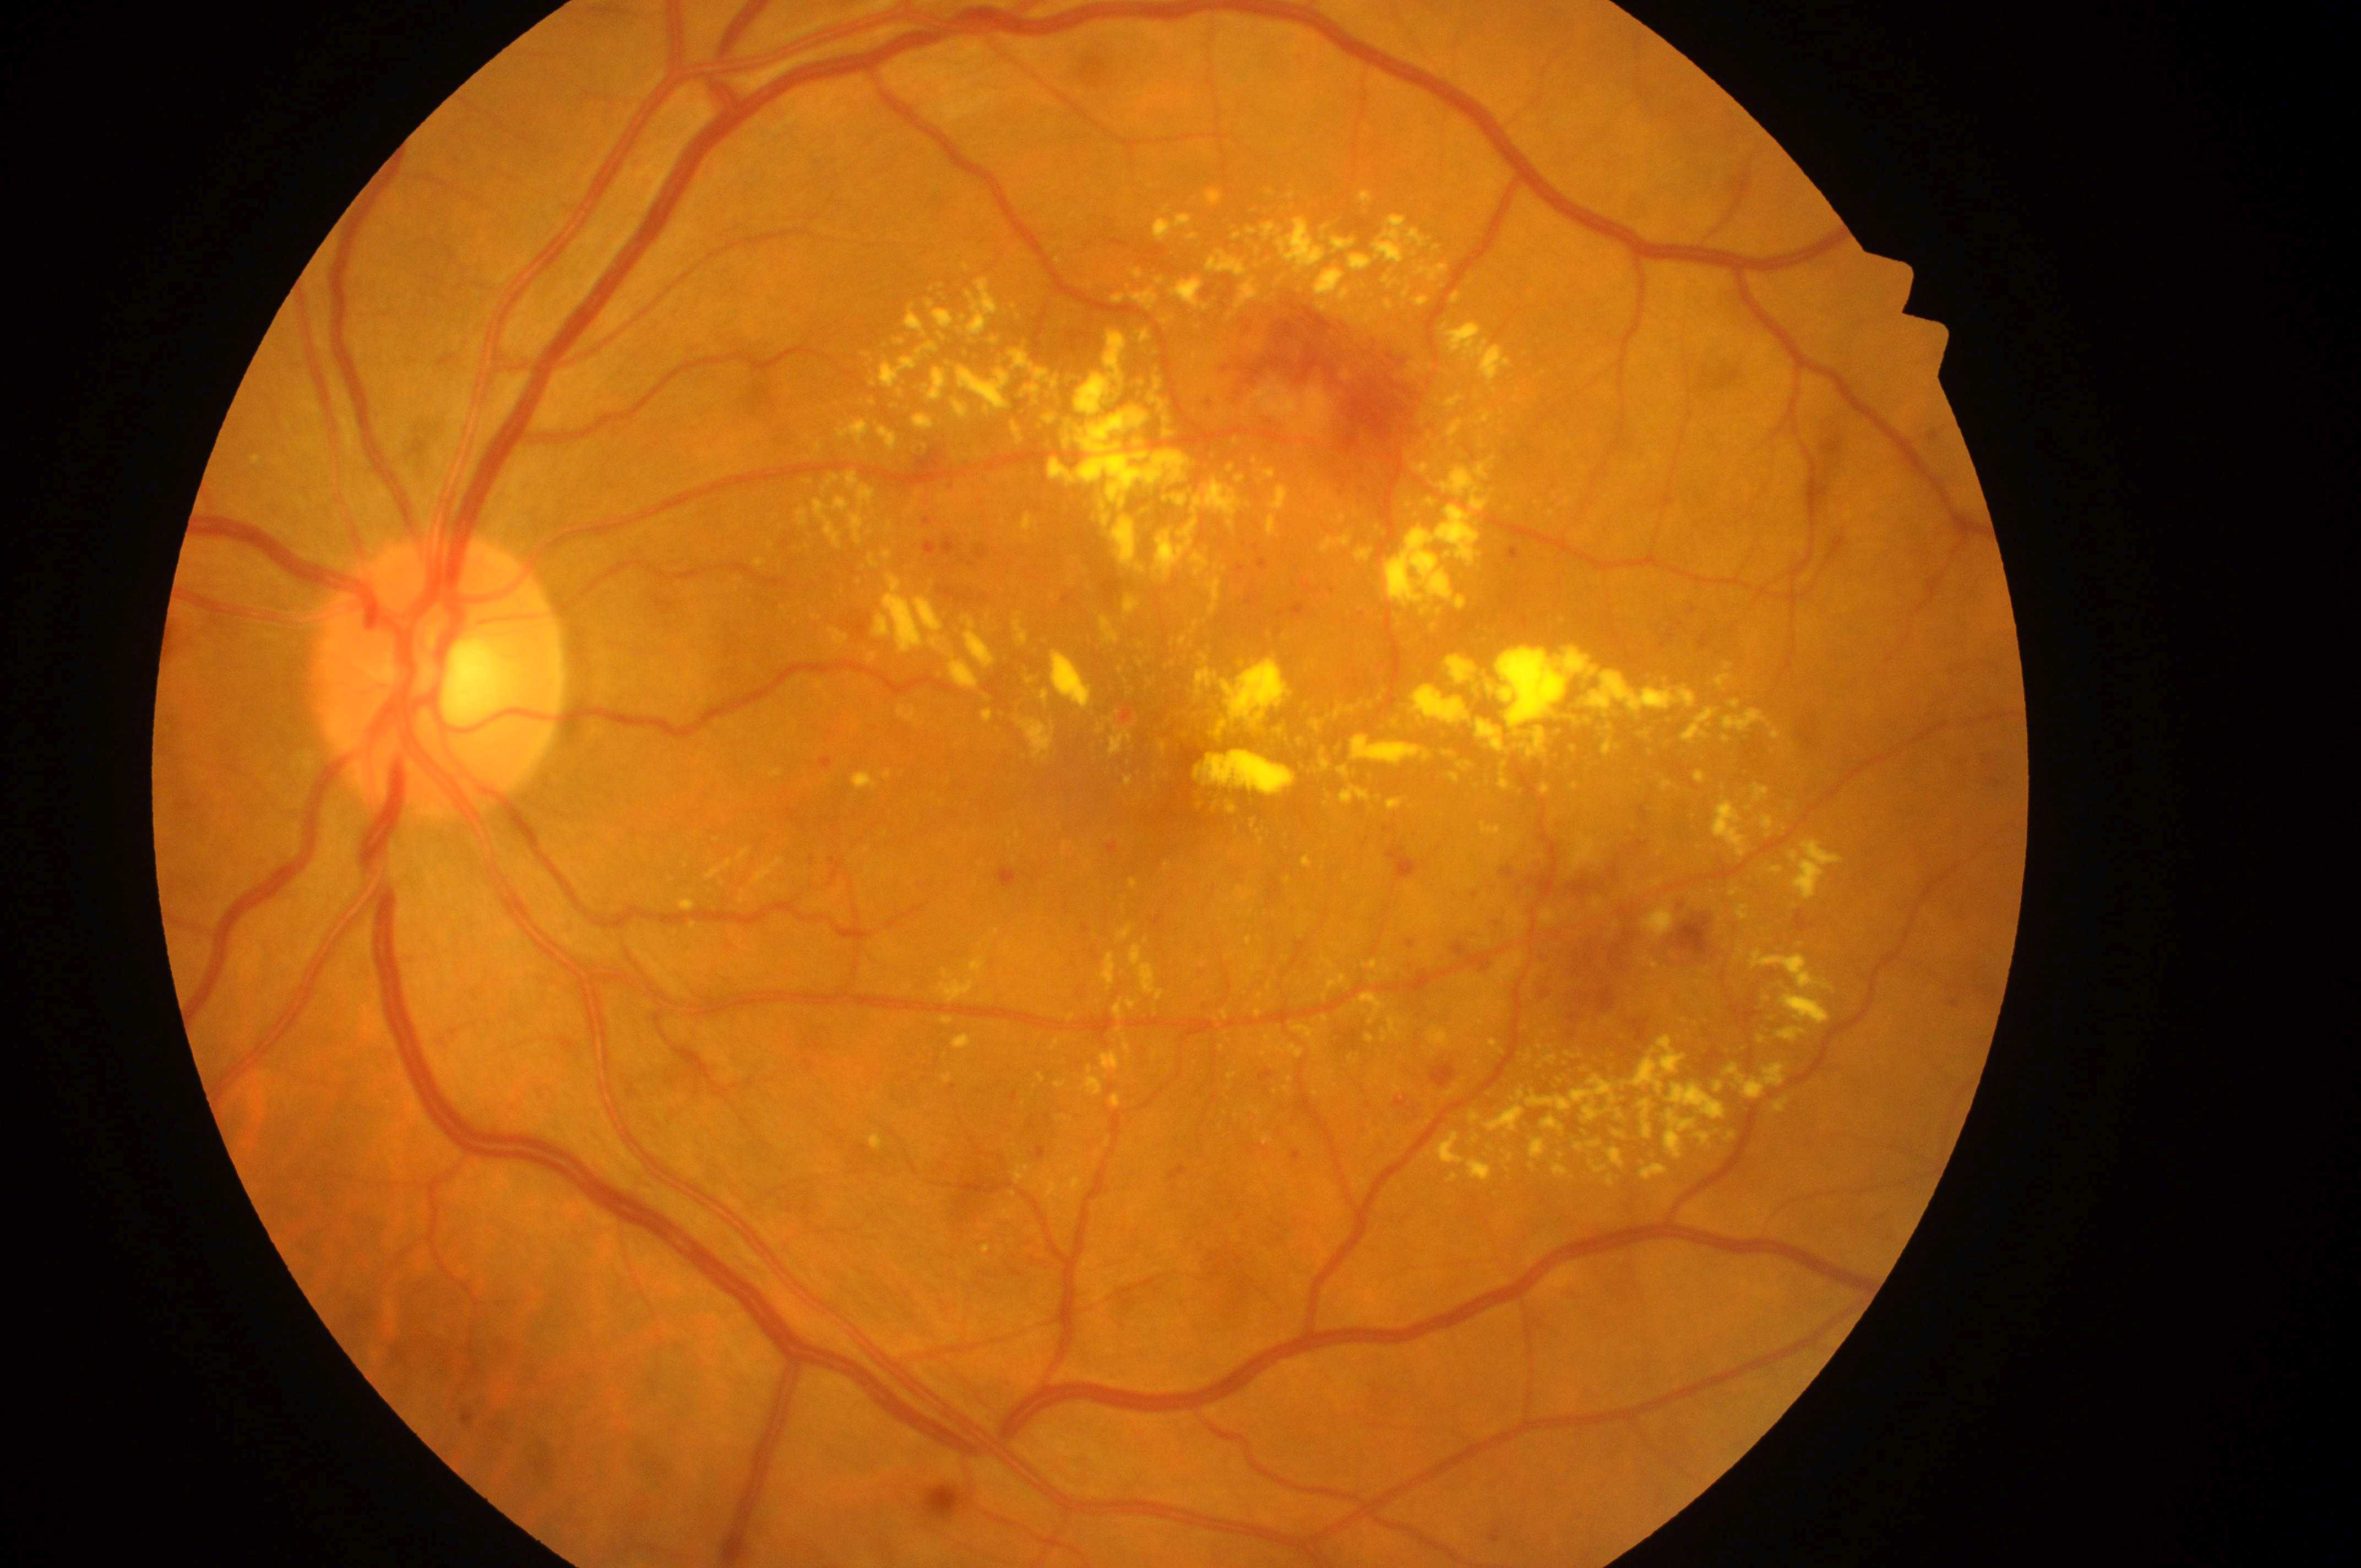
• retinopathy grade: severe NPDR (3)
• laterality: the left eye
• diabetic macular edema: high risk (grade 2)
• fovea center: 1128, 787
• the optic disc: 433, 690